Fundus photo; 1932x1932
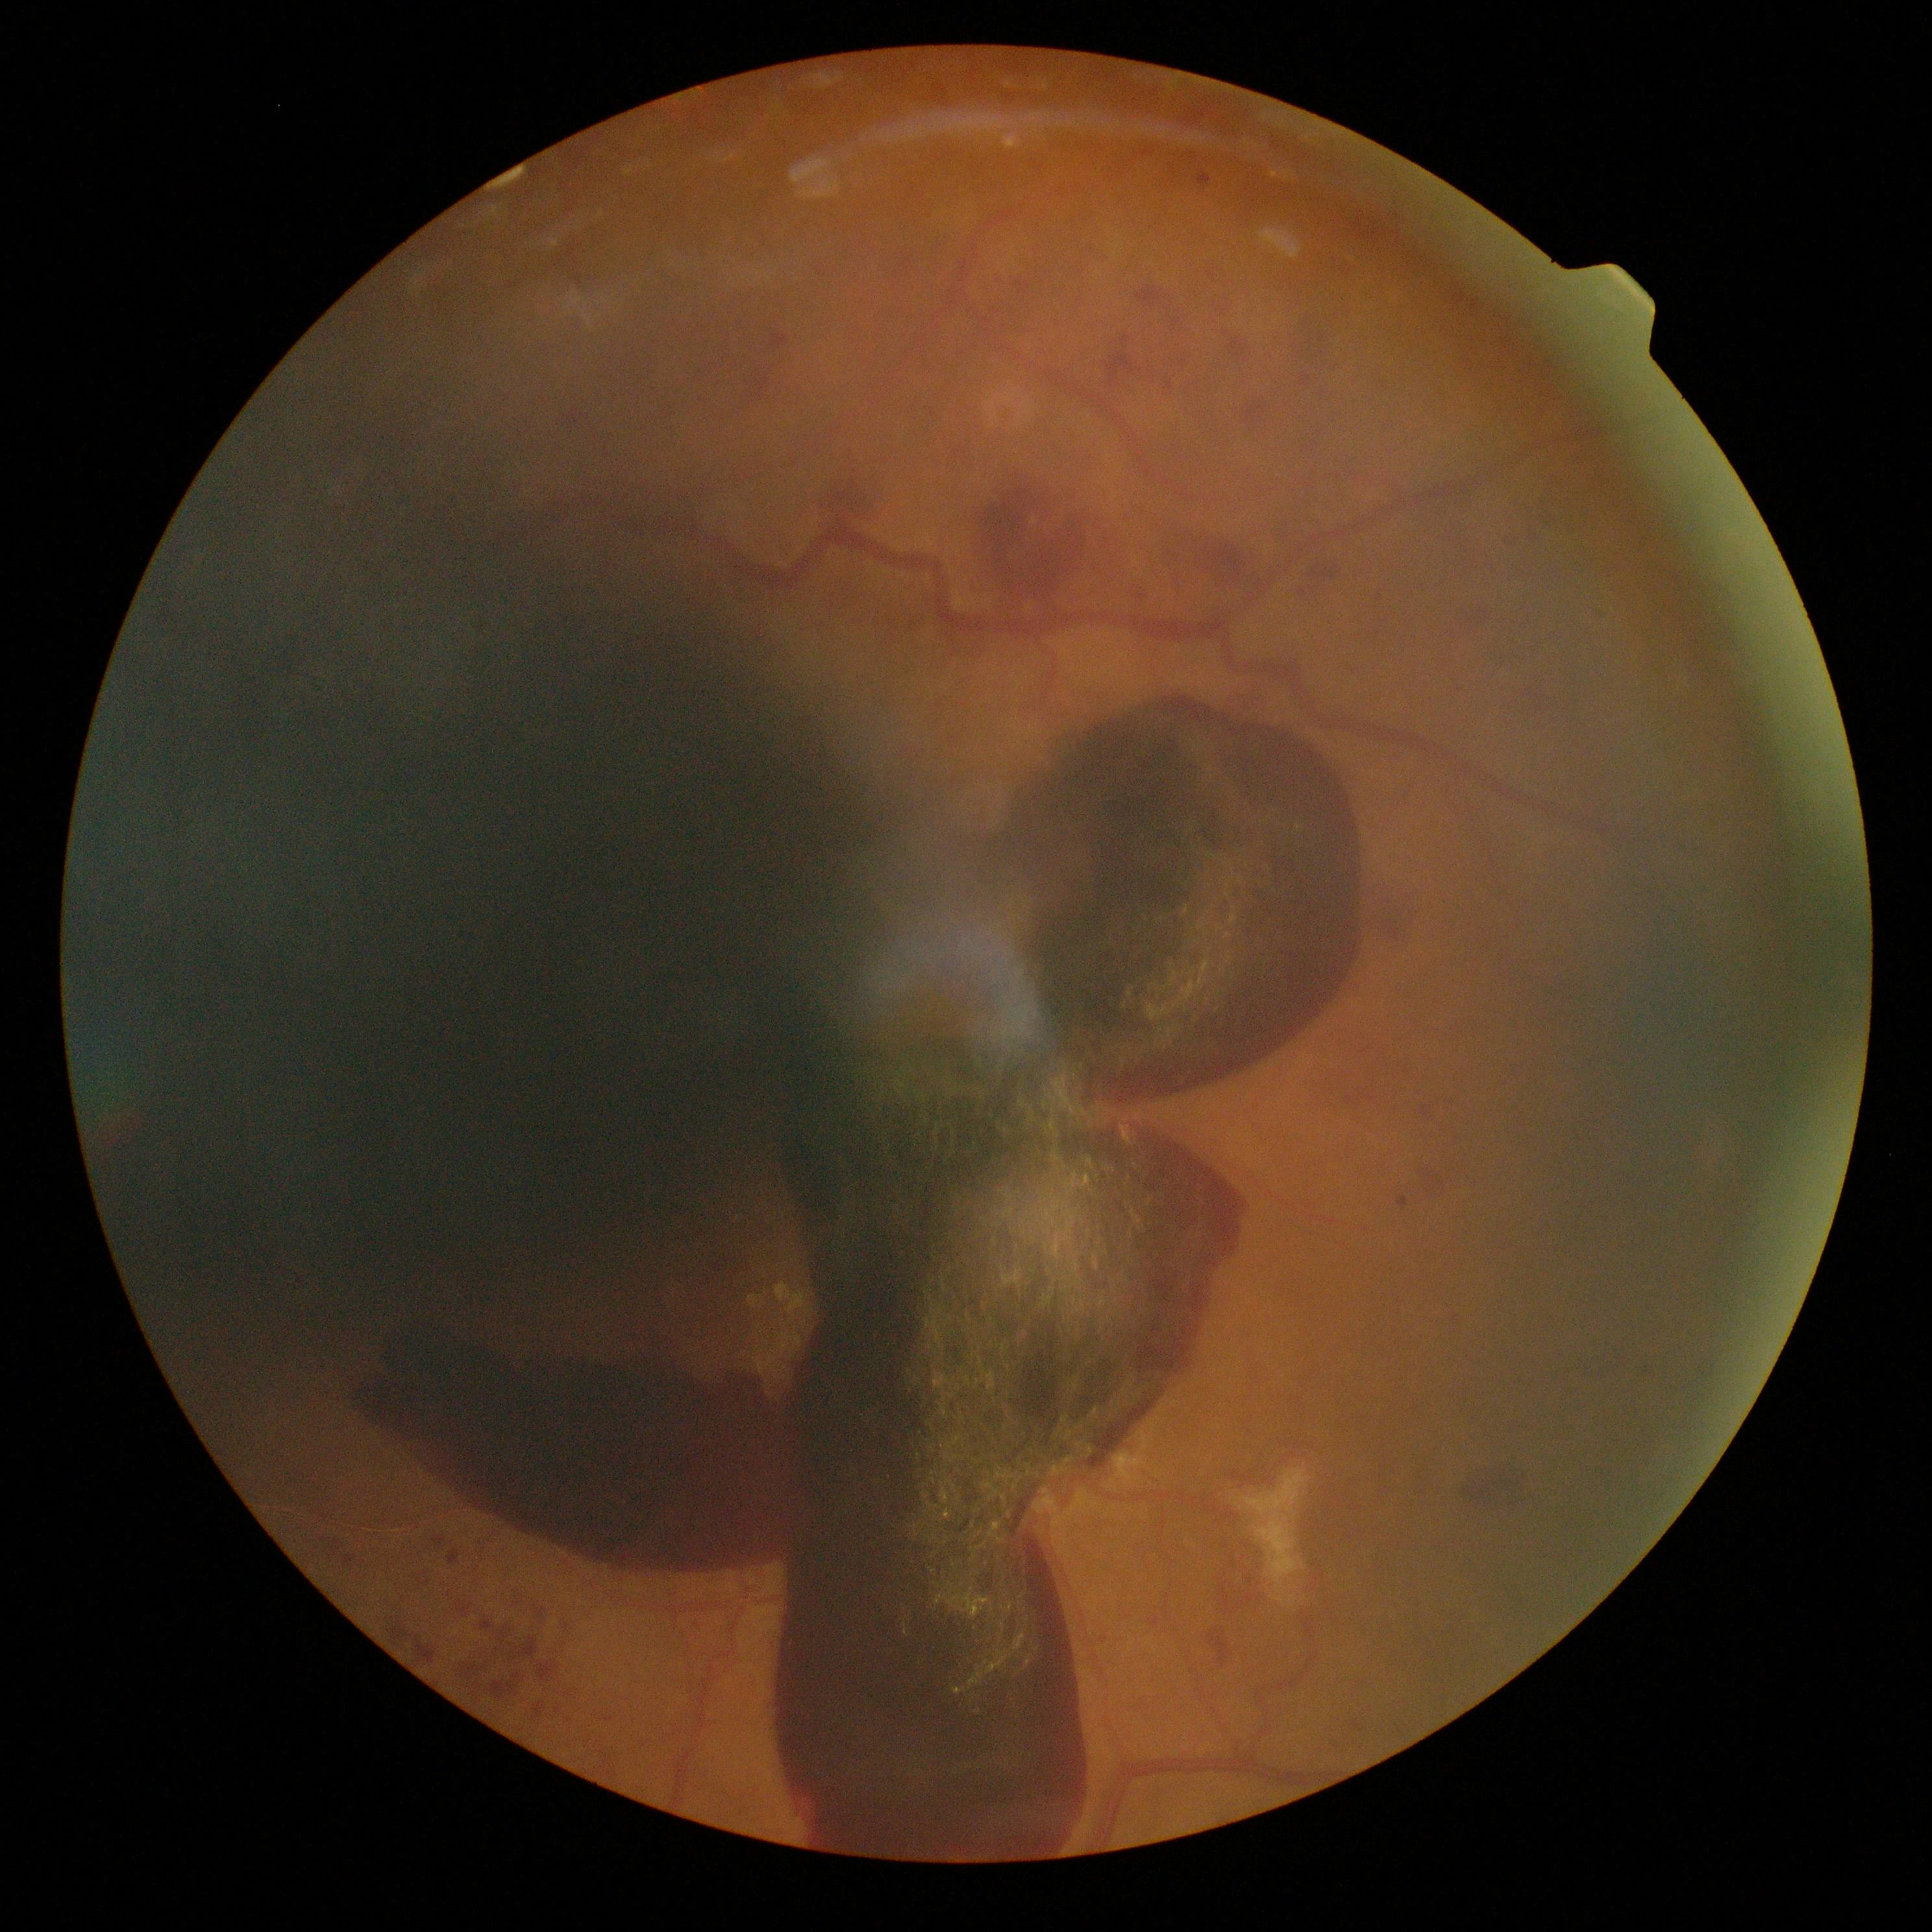

{"dr_grade": "PDR (grade 4) — neovascularization and/or vitreous/pre-retinal hemorrhage"}